Color fundus image · 2212x1659: 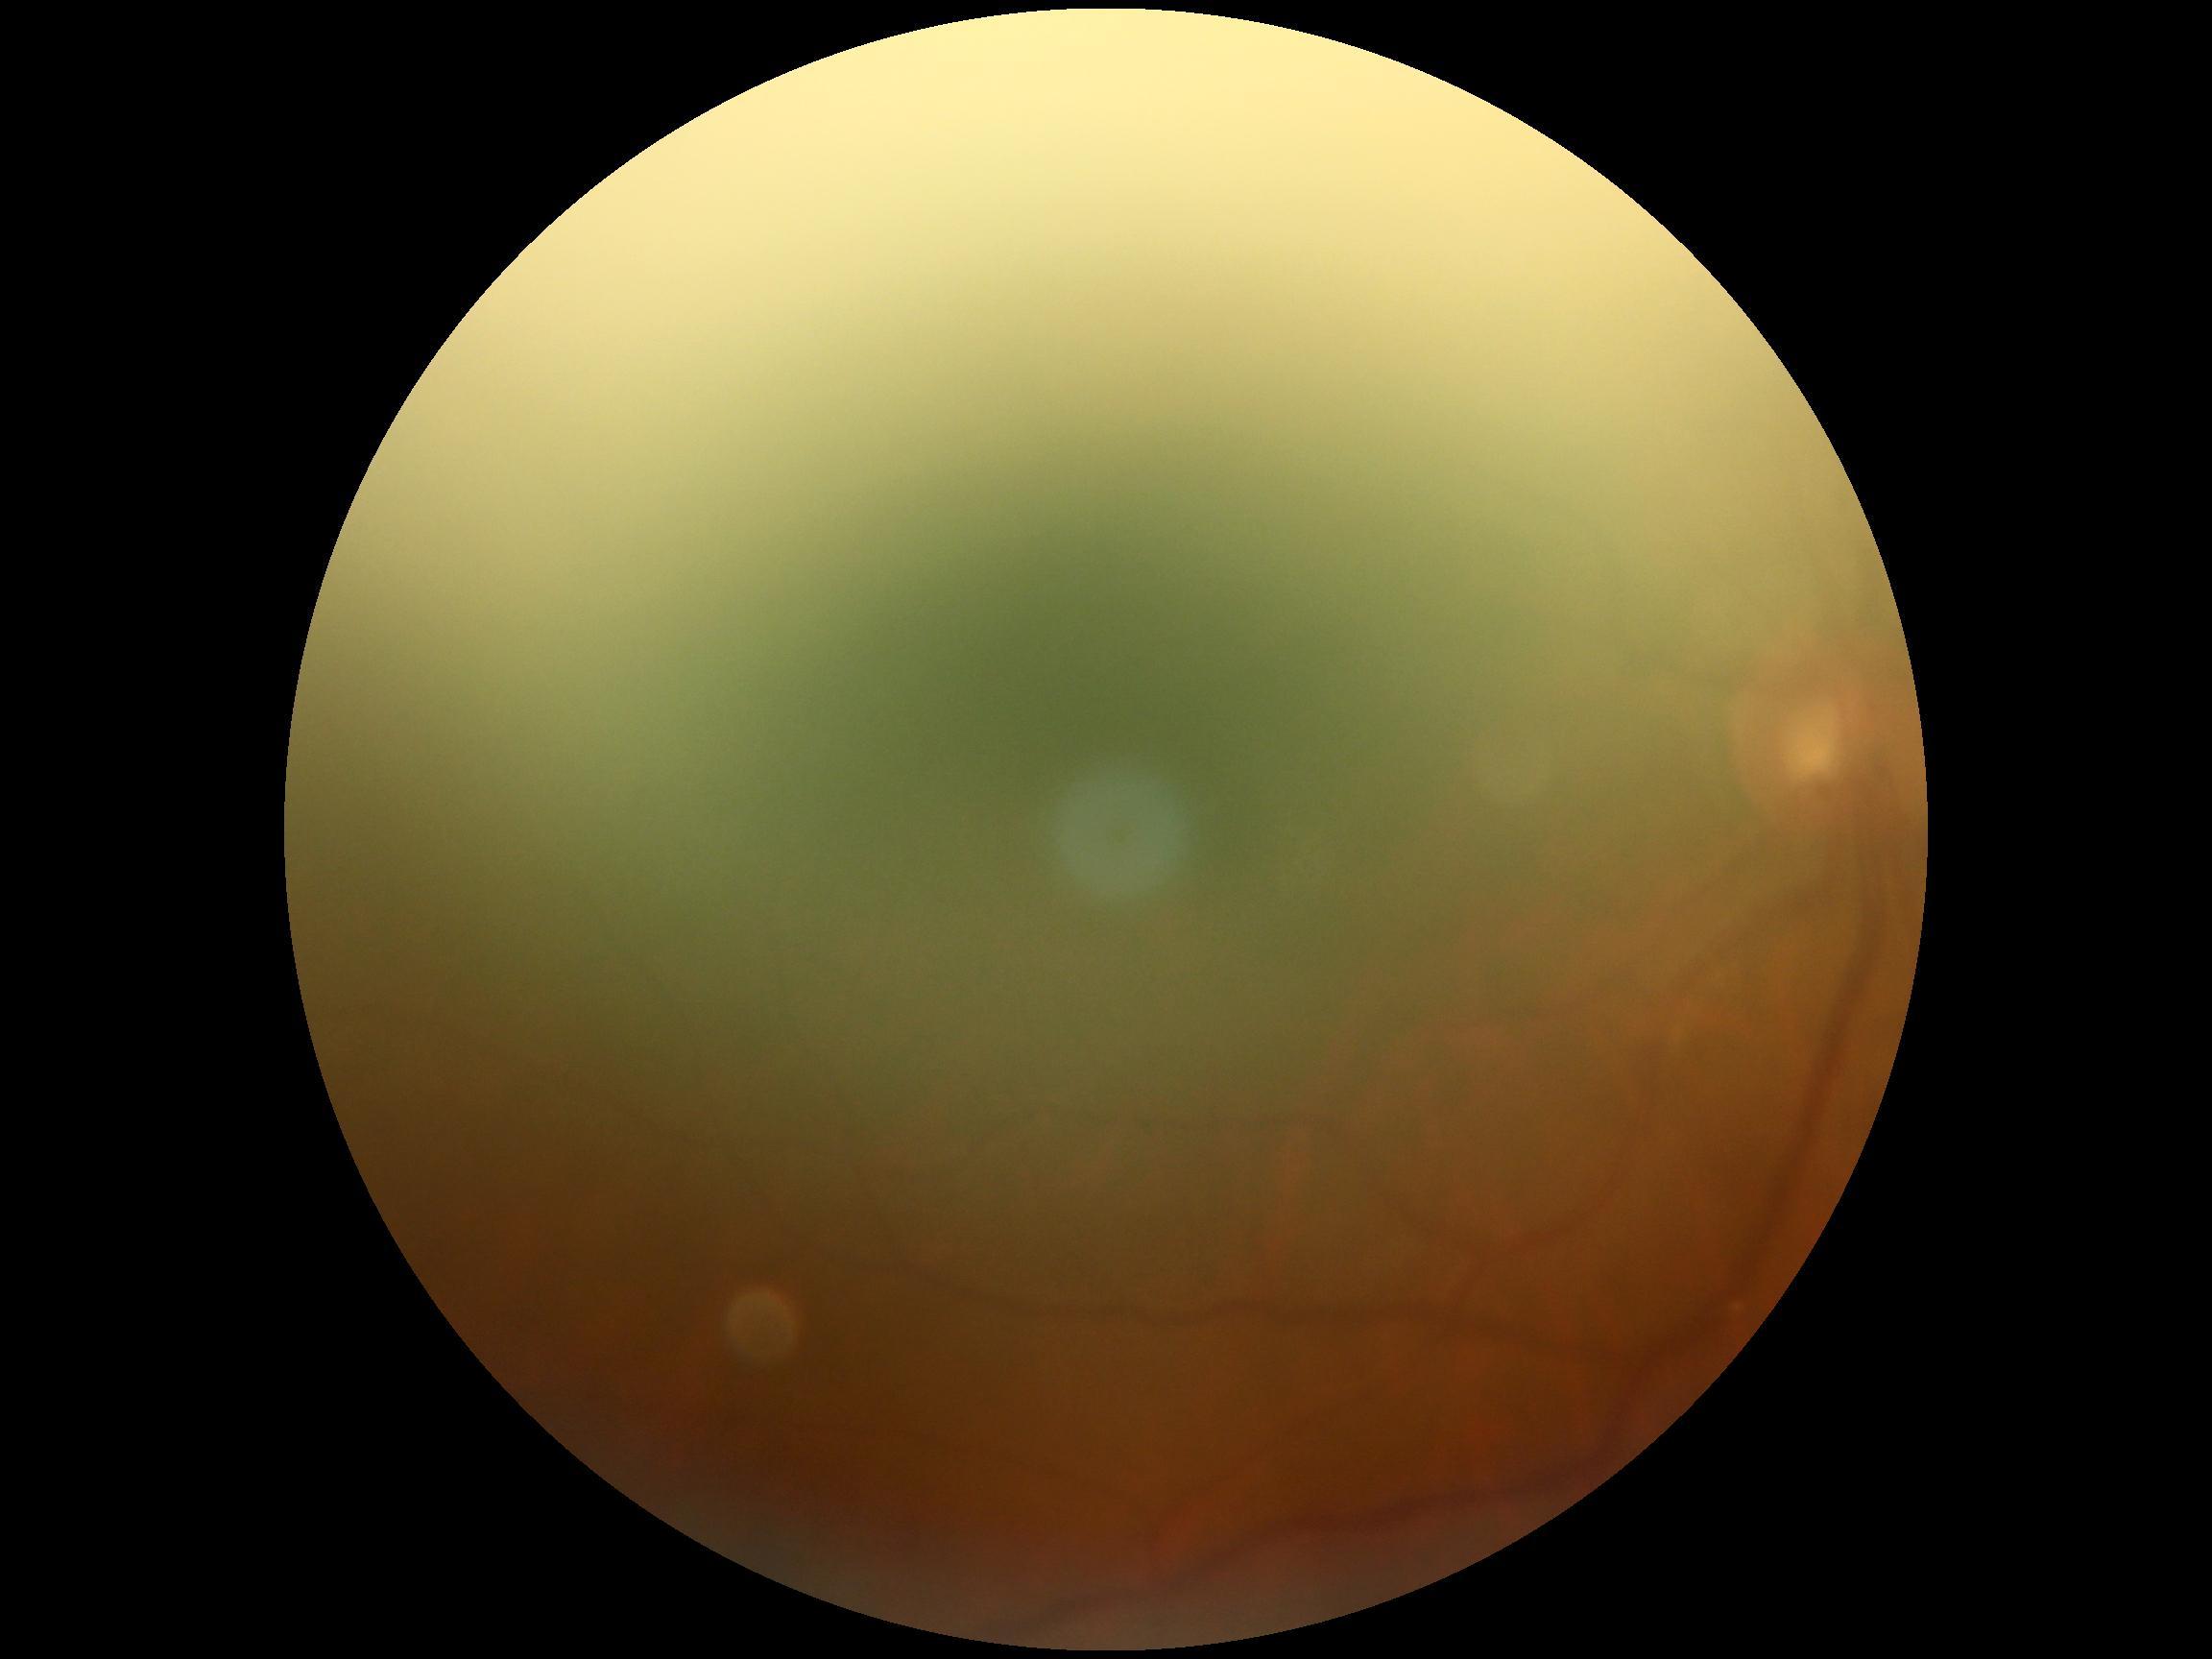 Ungradable image — DR severity cannot be determined.
DR stage is ungradable.